Fundus photo · Davis DR grading · 45 degree fundus photograph · no pharmacologic dilation · 848x848 · acquired with a NIDEK AFC-230 — 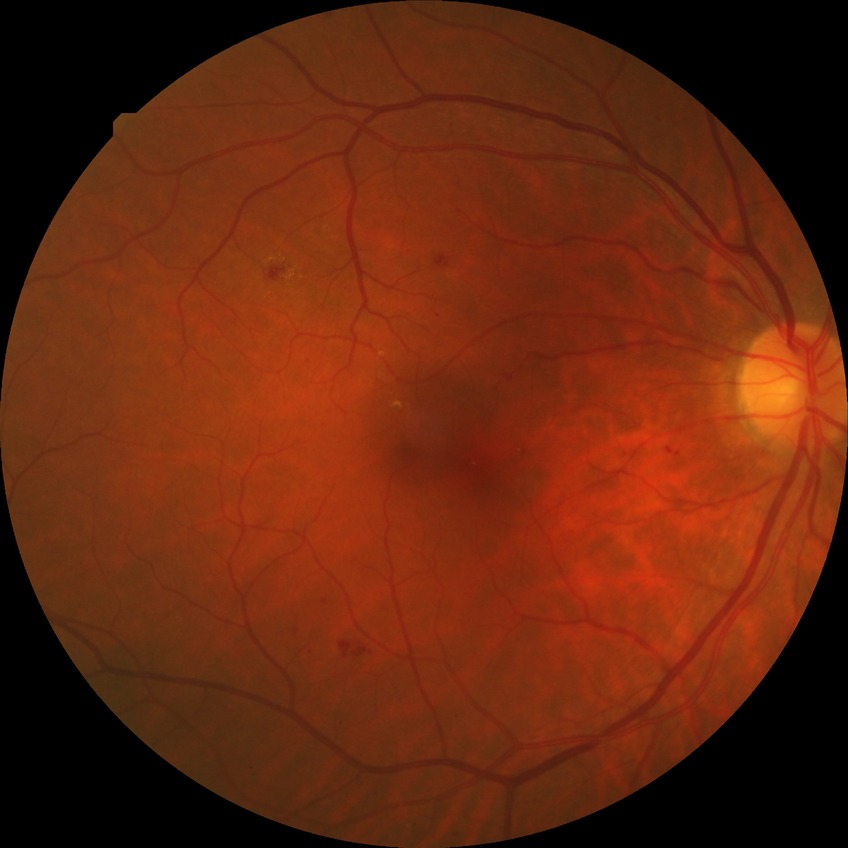
Annotations:
- diabetic retinopathy (DR): simple diabetic retinopathy (SDR)